45° field of view: 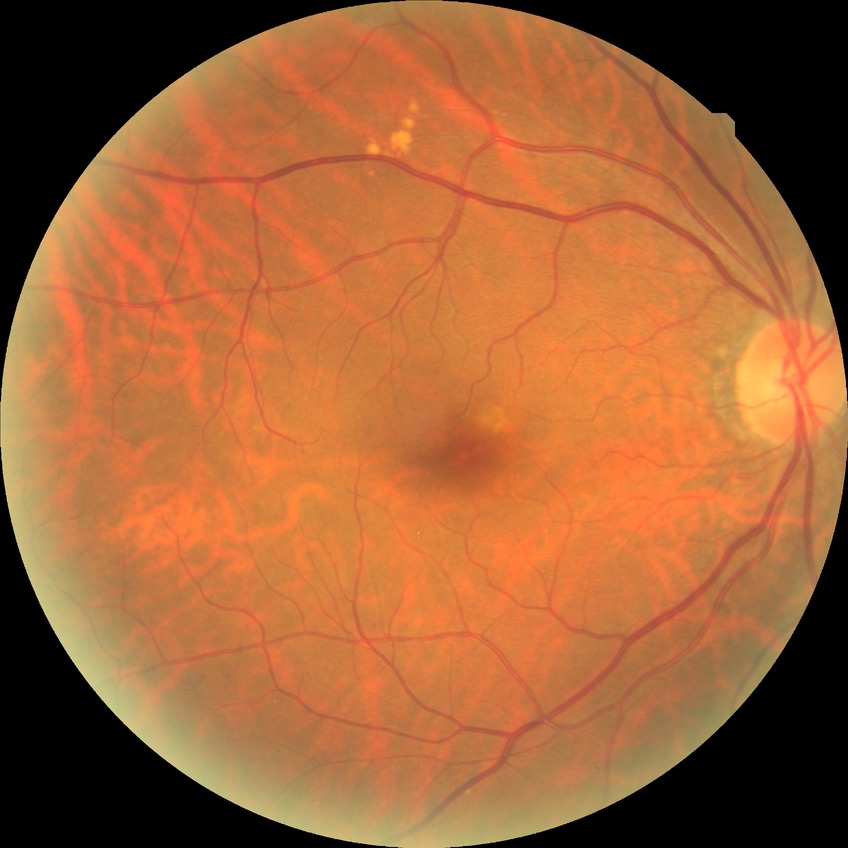 Davis stage is NDR.
No signs of diabetic retinopathy.